Wide-field fundus photograph from neonatal ROP screening; 640 by 480 pixels; 130° field of view (Clarity RetCam 3)
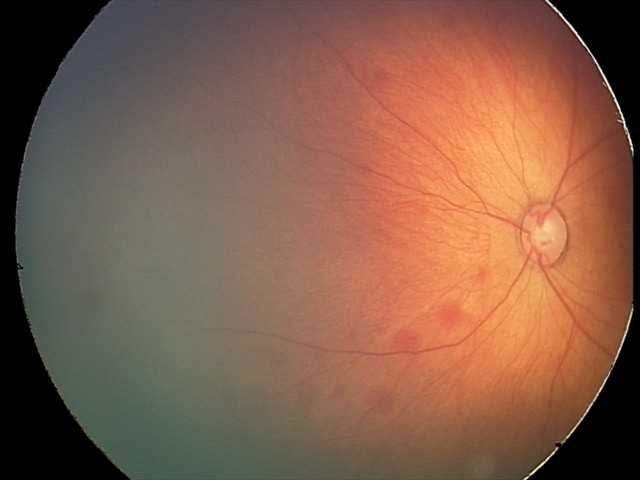

Impression = retinal hemorrhages.